Ultra-widefield (UWF) fundus image: 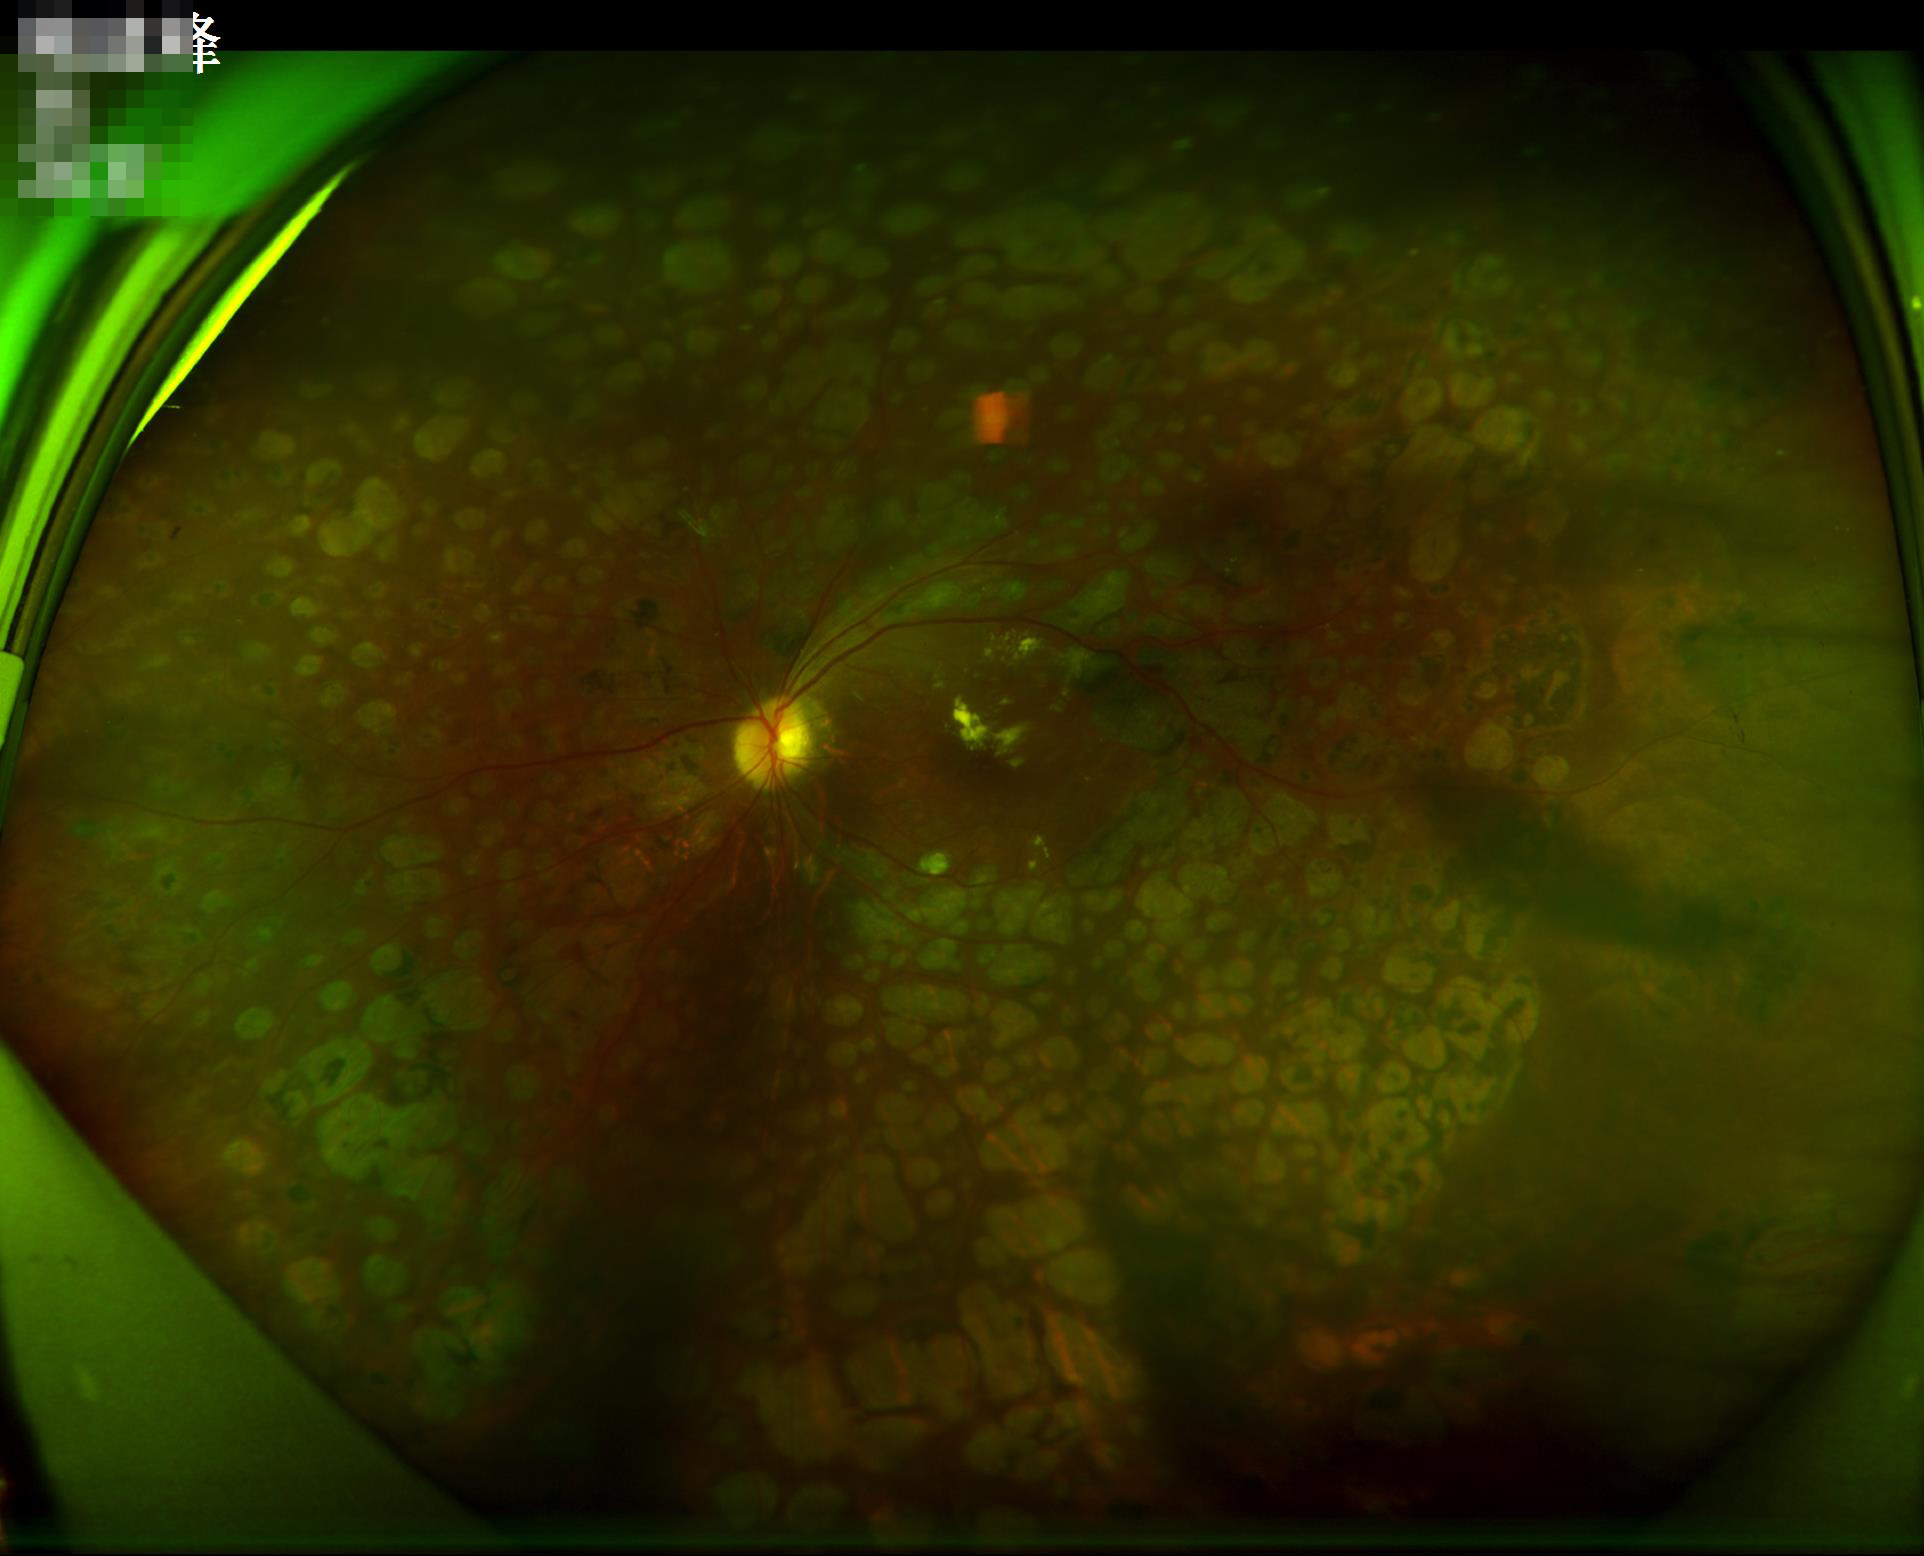 Illumination and color are suboptimal. Poor dynamic range. Image is sharp throughout the field. Overall image quality is poor.